1440x1080; infant wide-field fundus photograph:
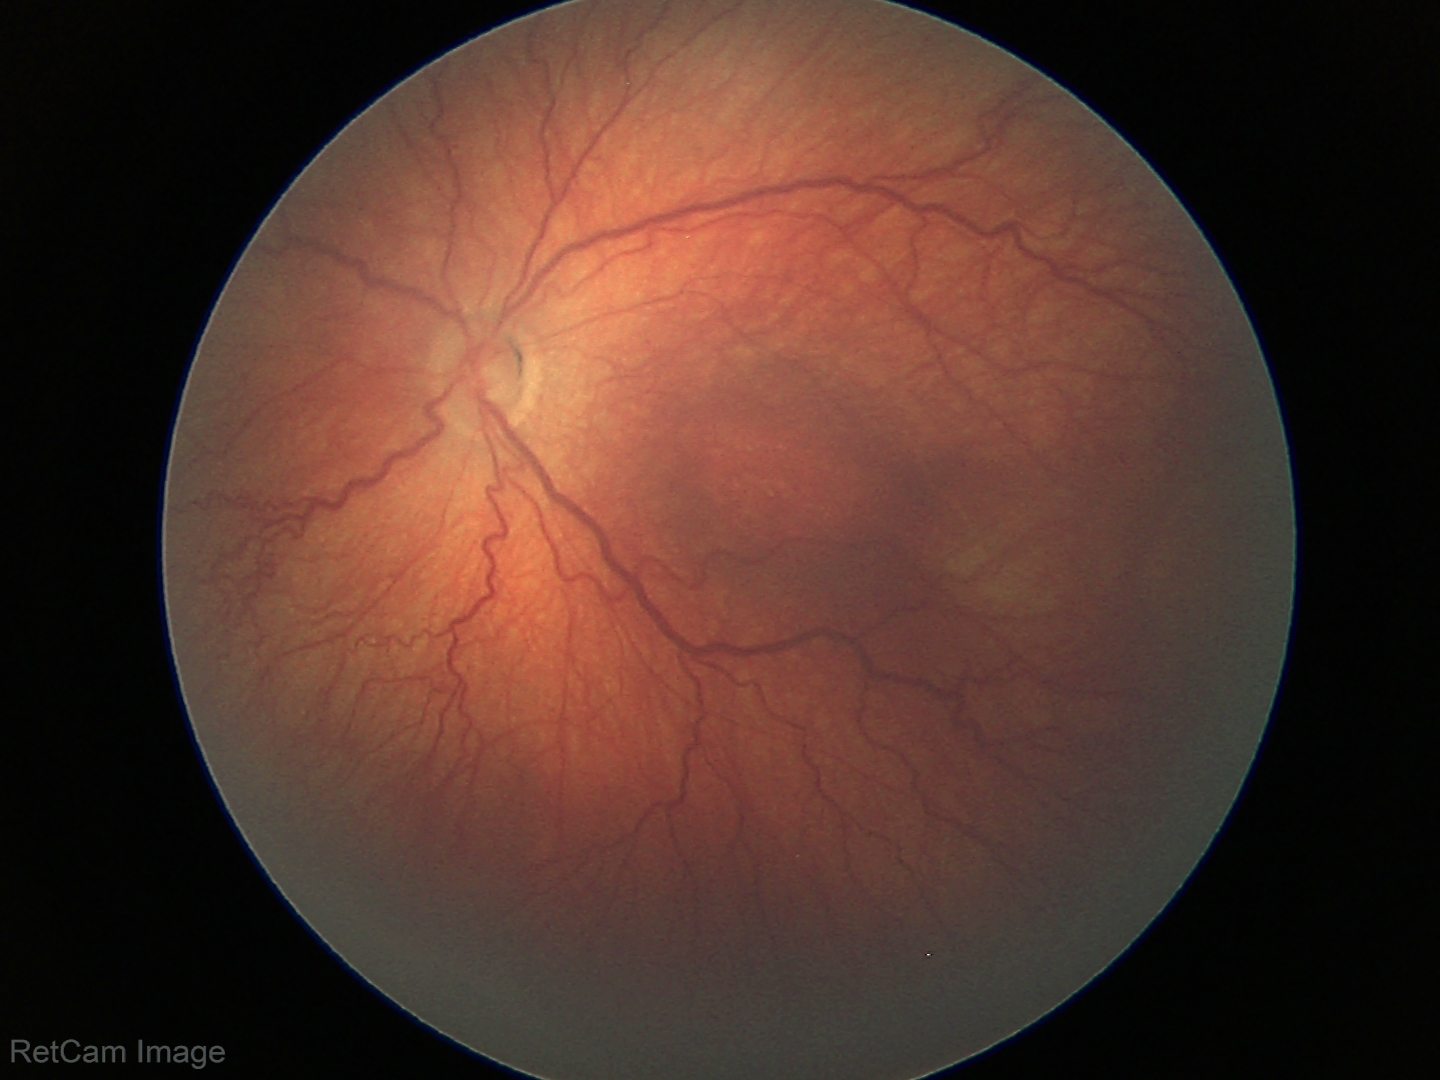
Plus disease = absent
finding = ROP stage 3